Graded on the modified Davis scale
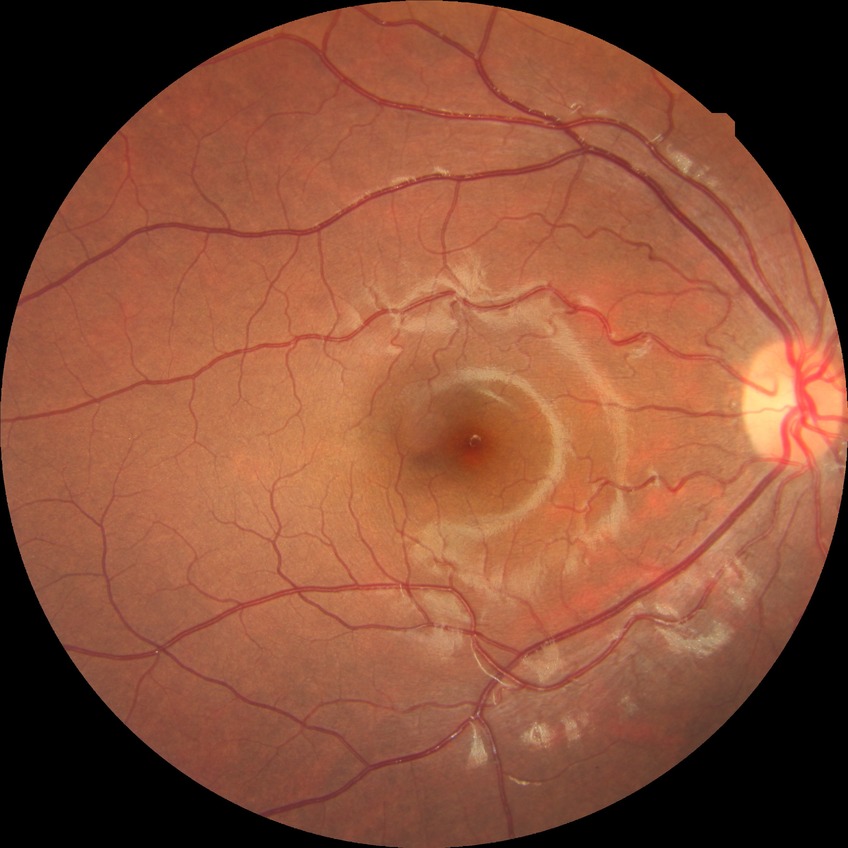 Diabetic retinopathy (DR) is NDR (no diabetic retinopathy).